45° FOV; nonmydriatic fundus photograph; 848x848px; DR severity per modified Davis staging.
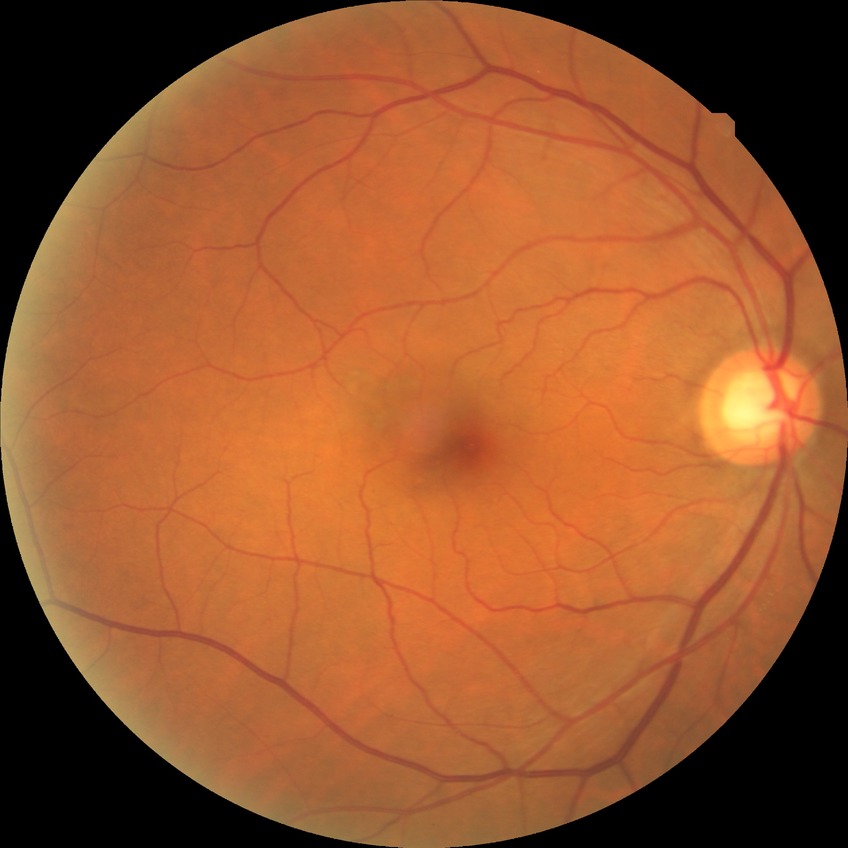 retinopathy grade: no diabetic retinopathy.